2212x1659 · 60° field of view · portable fundus camera image: 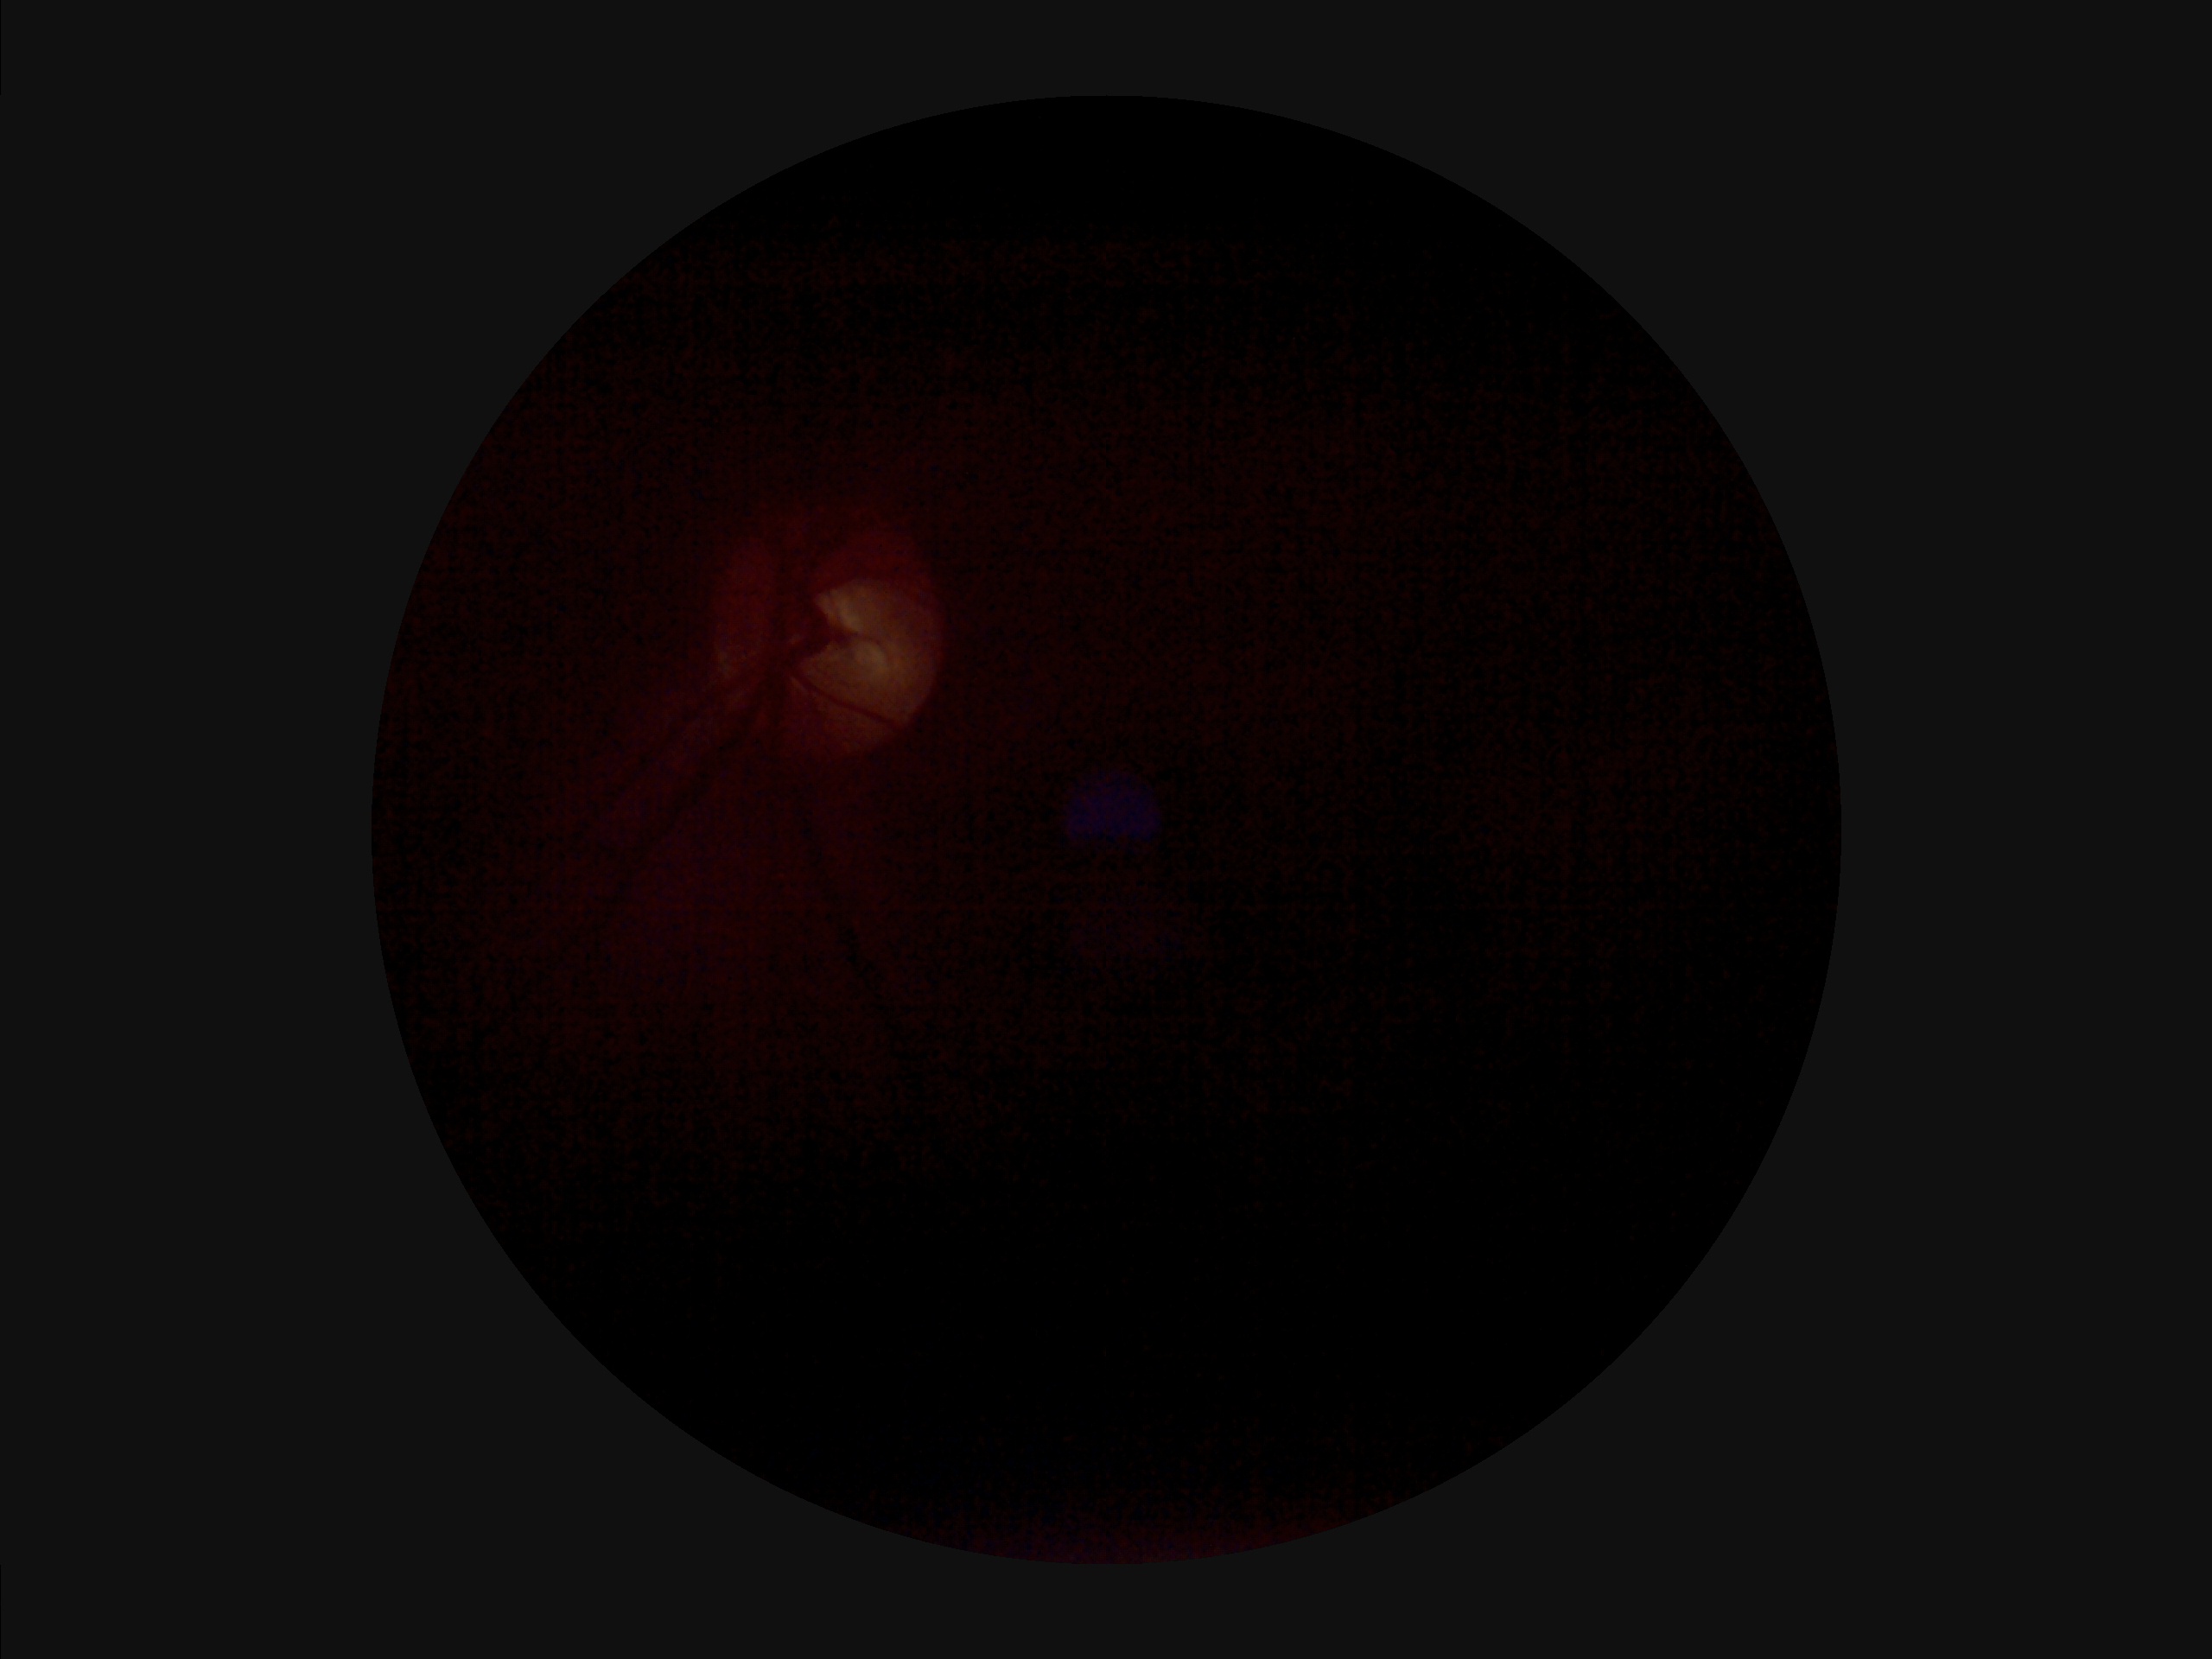

  clarity: out of focus
  illumination: uneven
  contrast: low
  overall_quality: suboptimal